FOV: 45 degrees
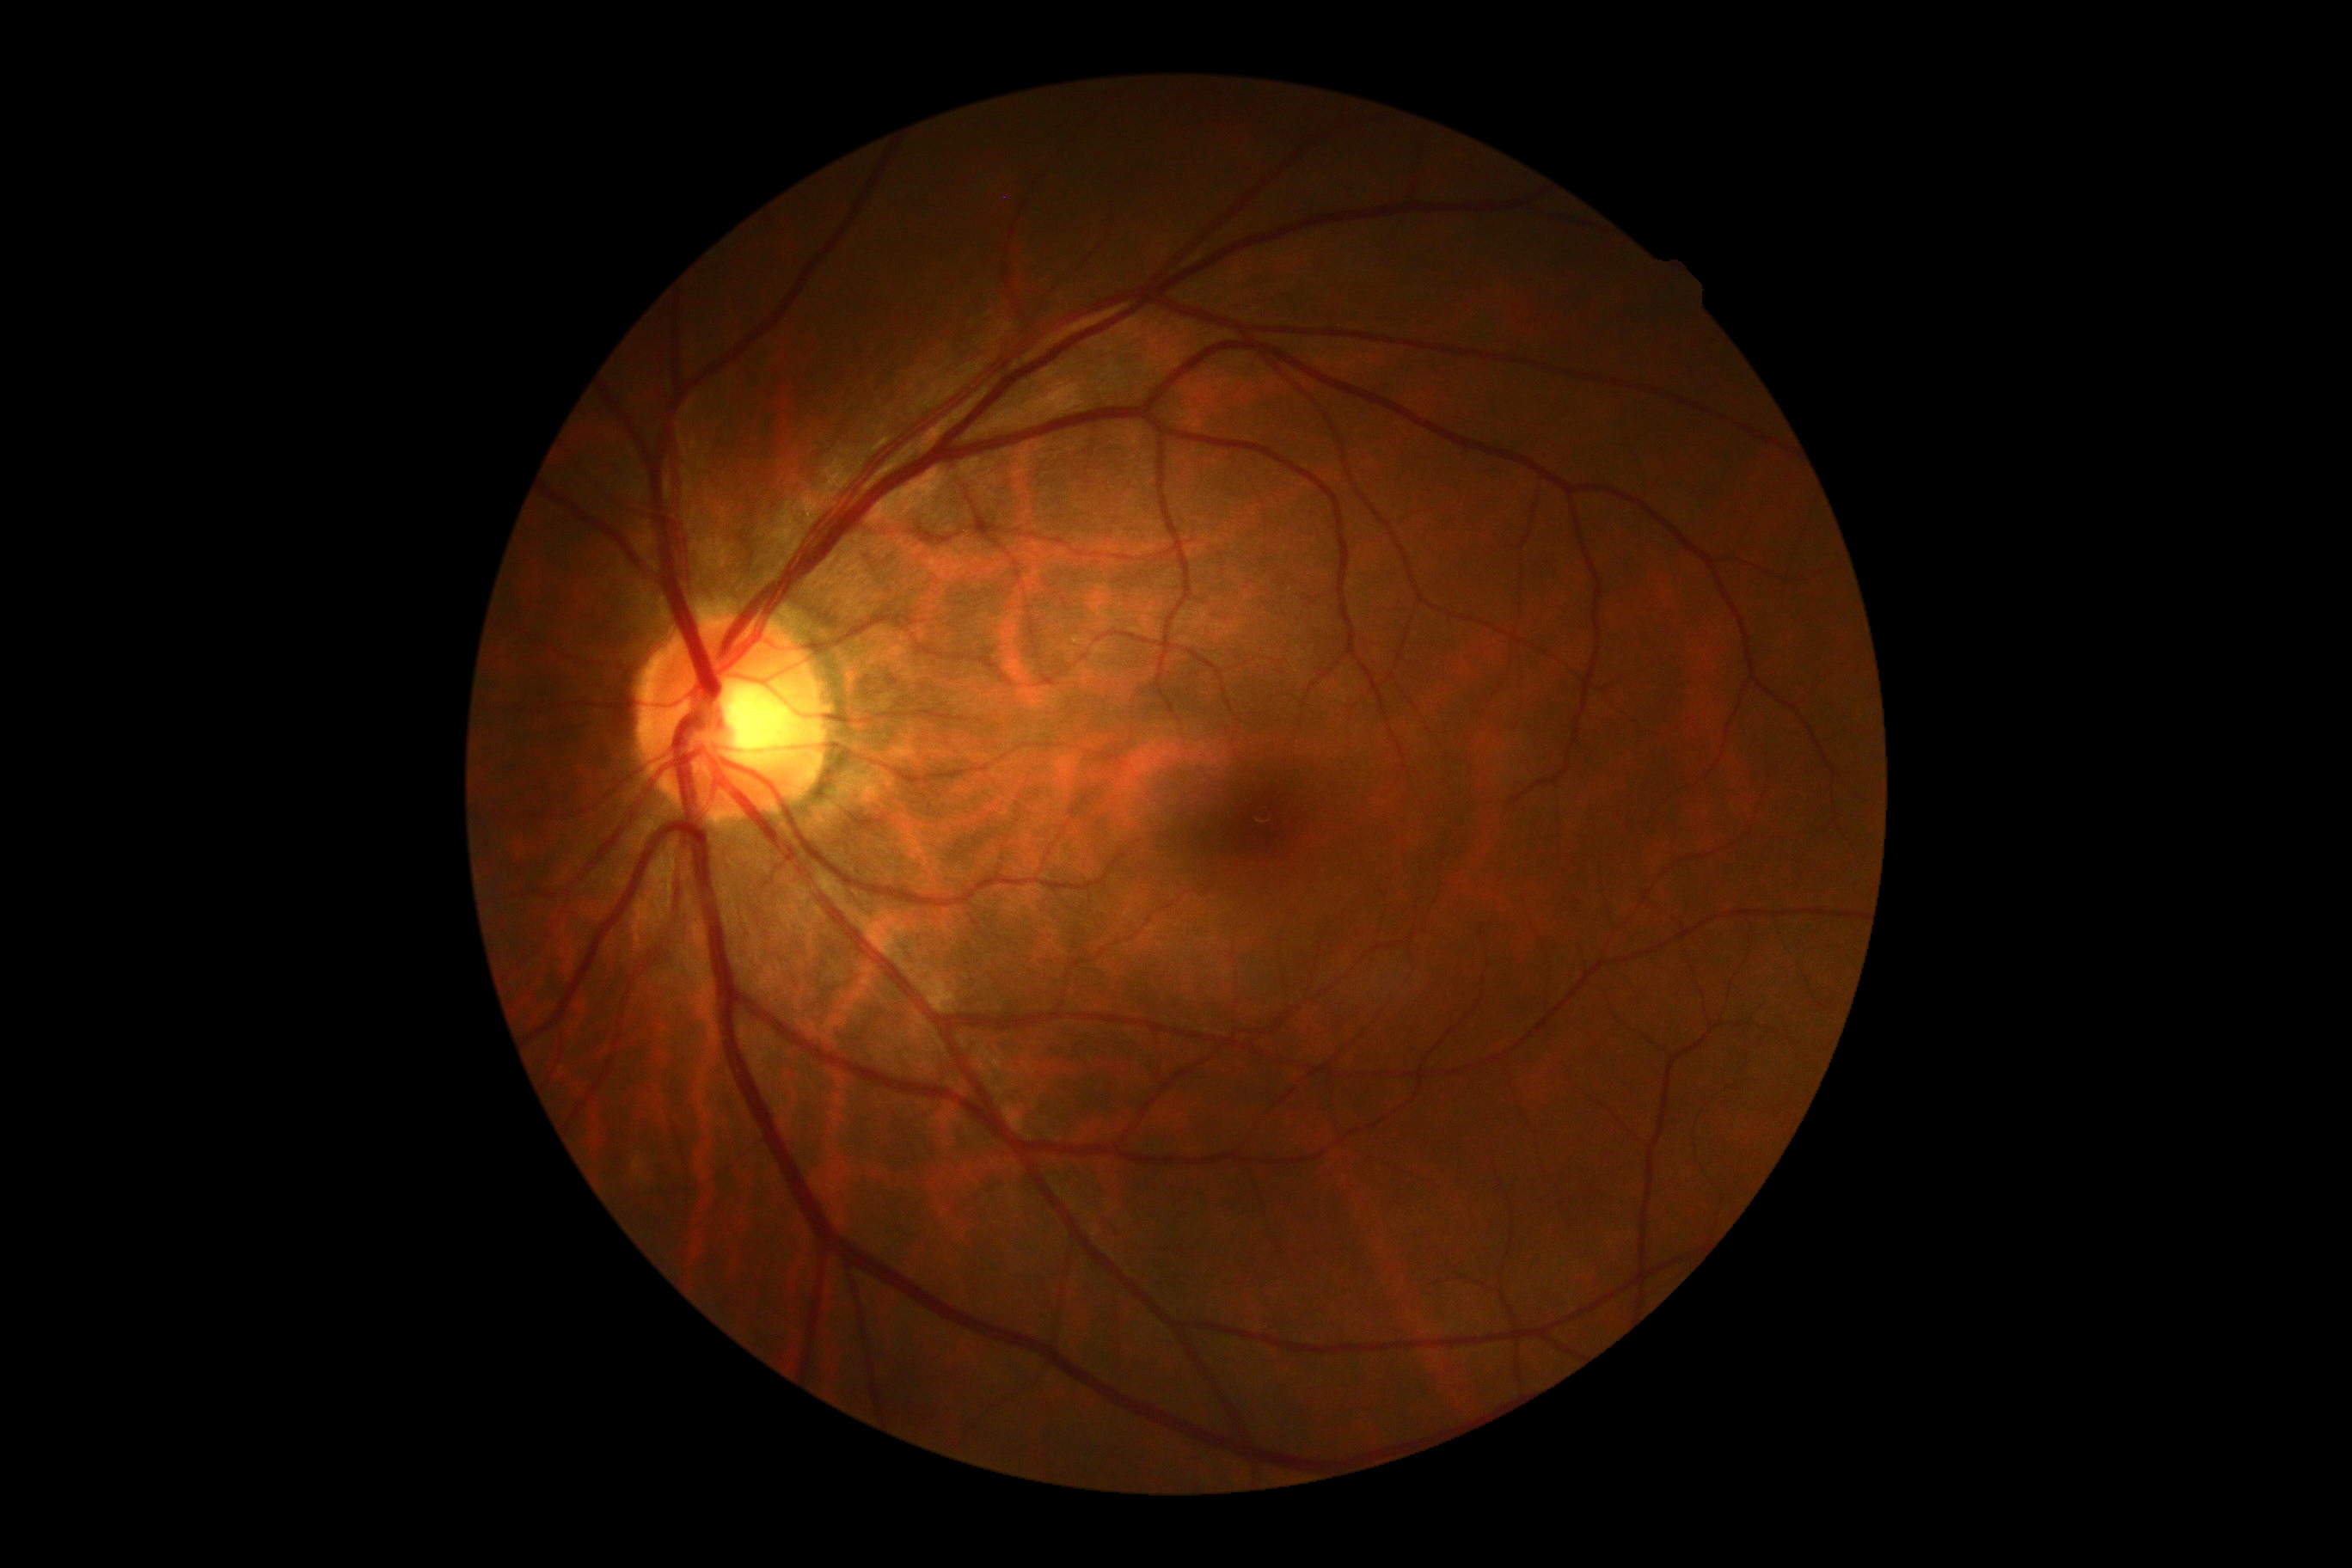
Diabetic retinopathy severity: no apparent retinopathy (grade 0) — no visible signs of diabetic retinopathy.